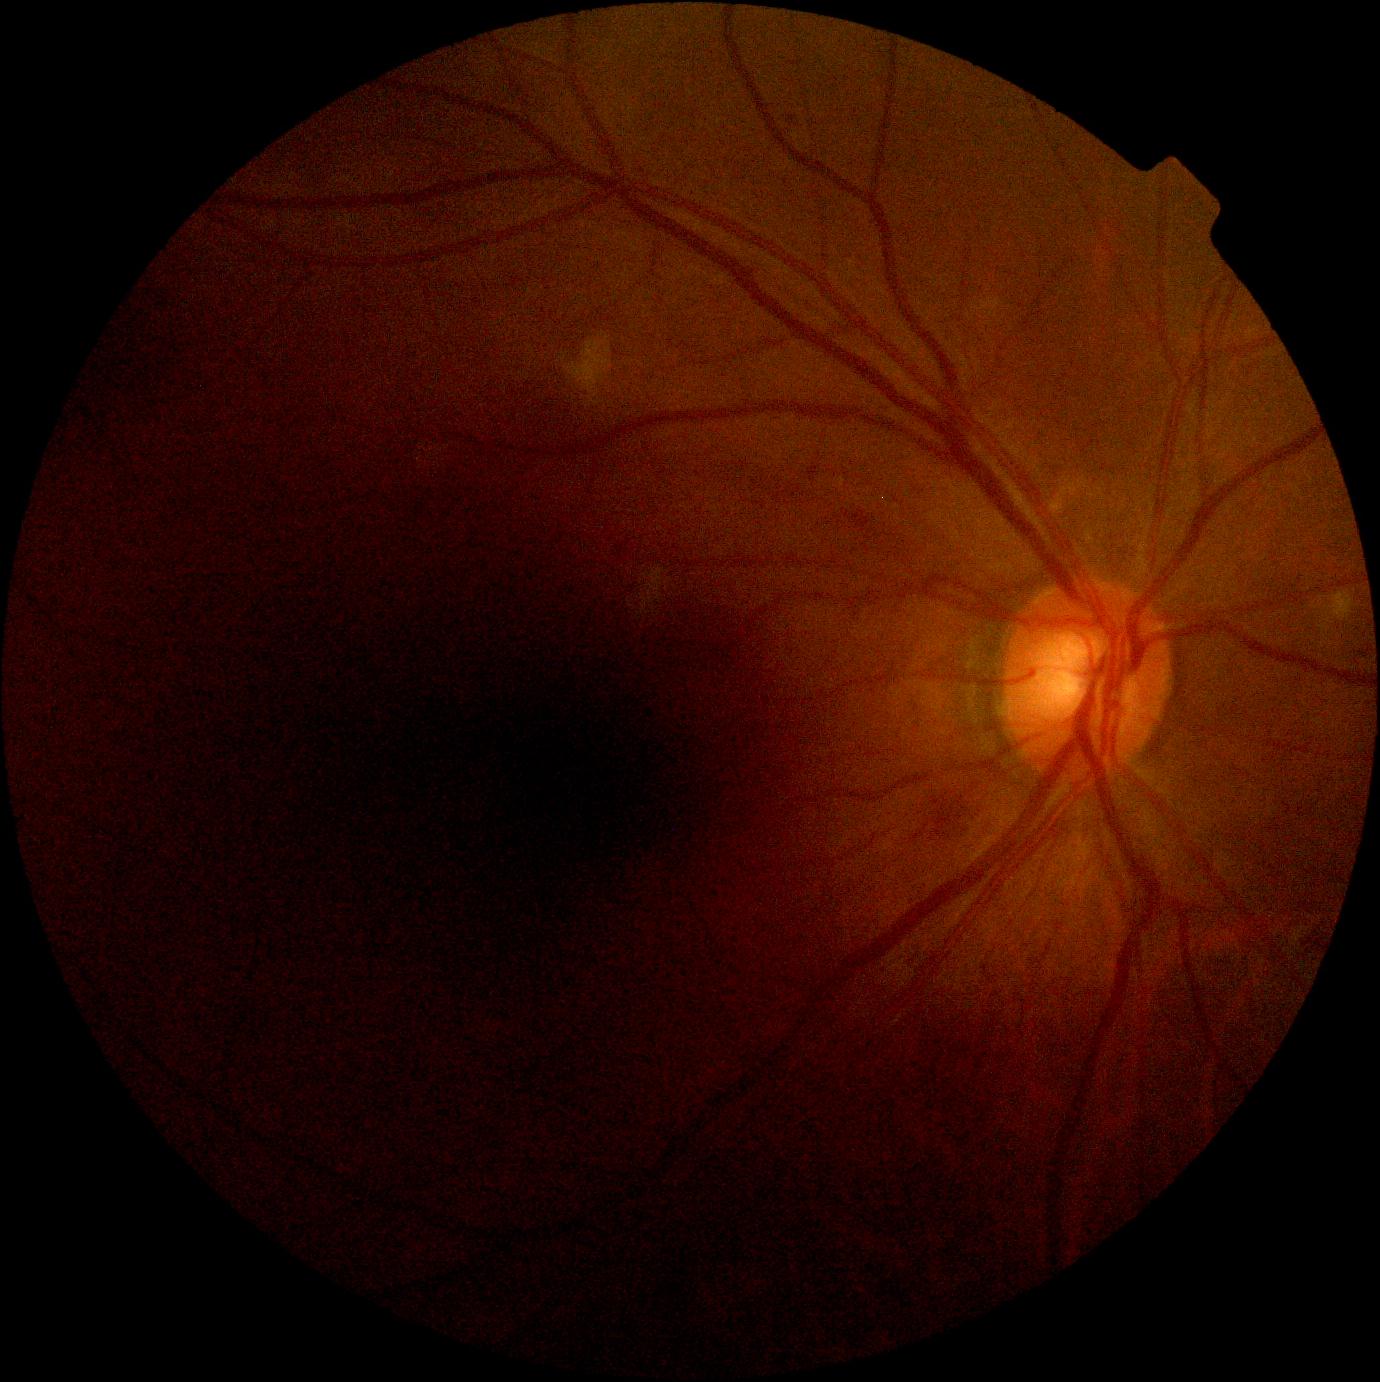

{
  "dr_grade": "grade 2"
}